Image size 1932x1932.
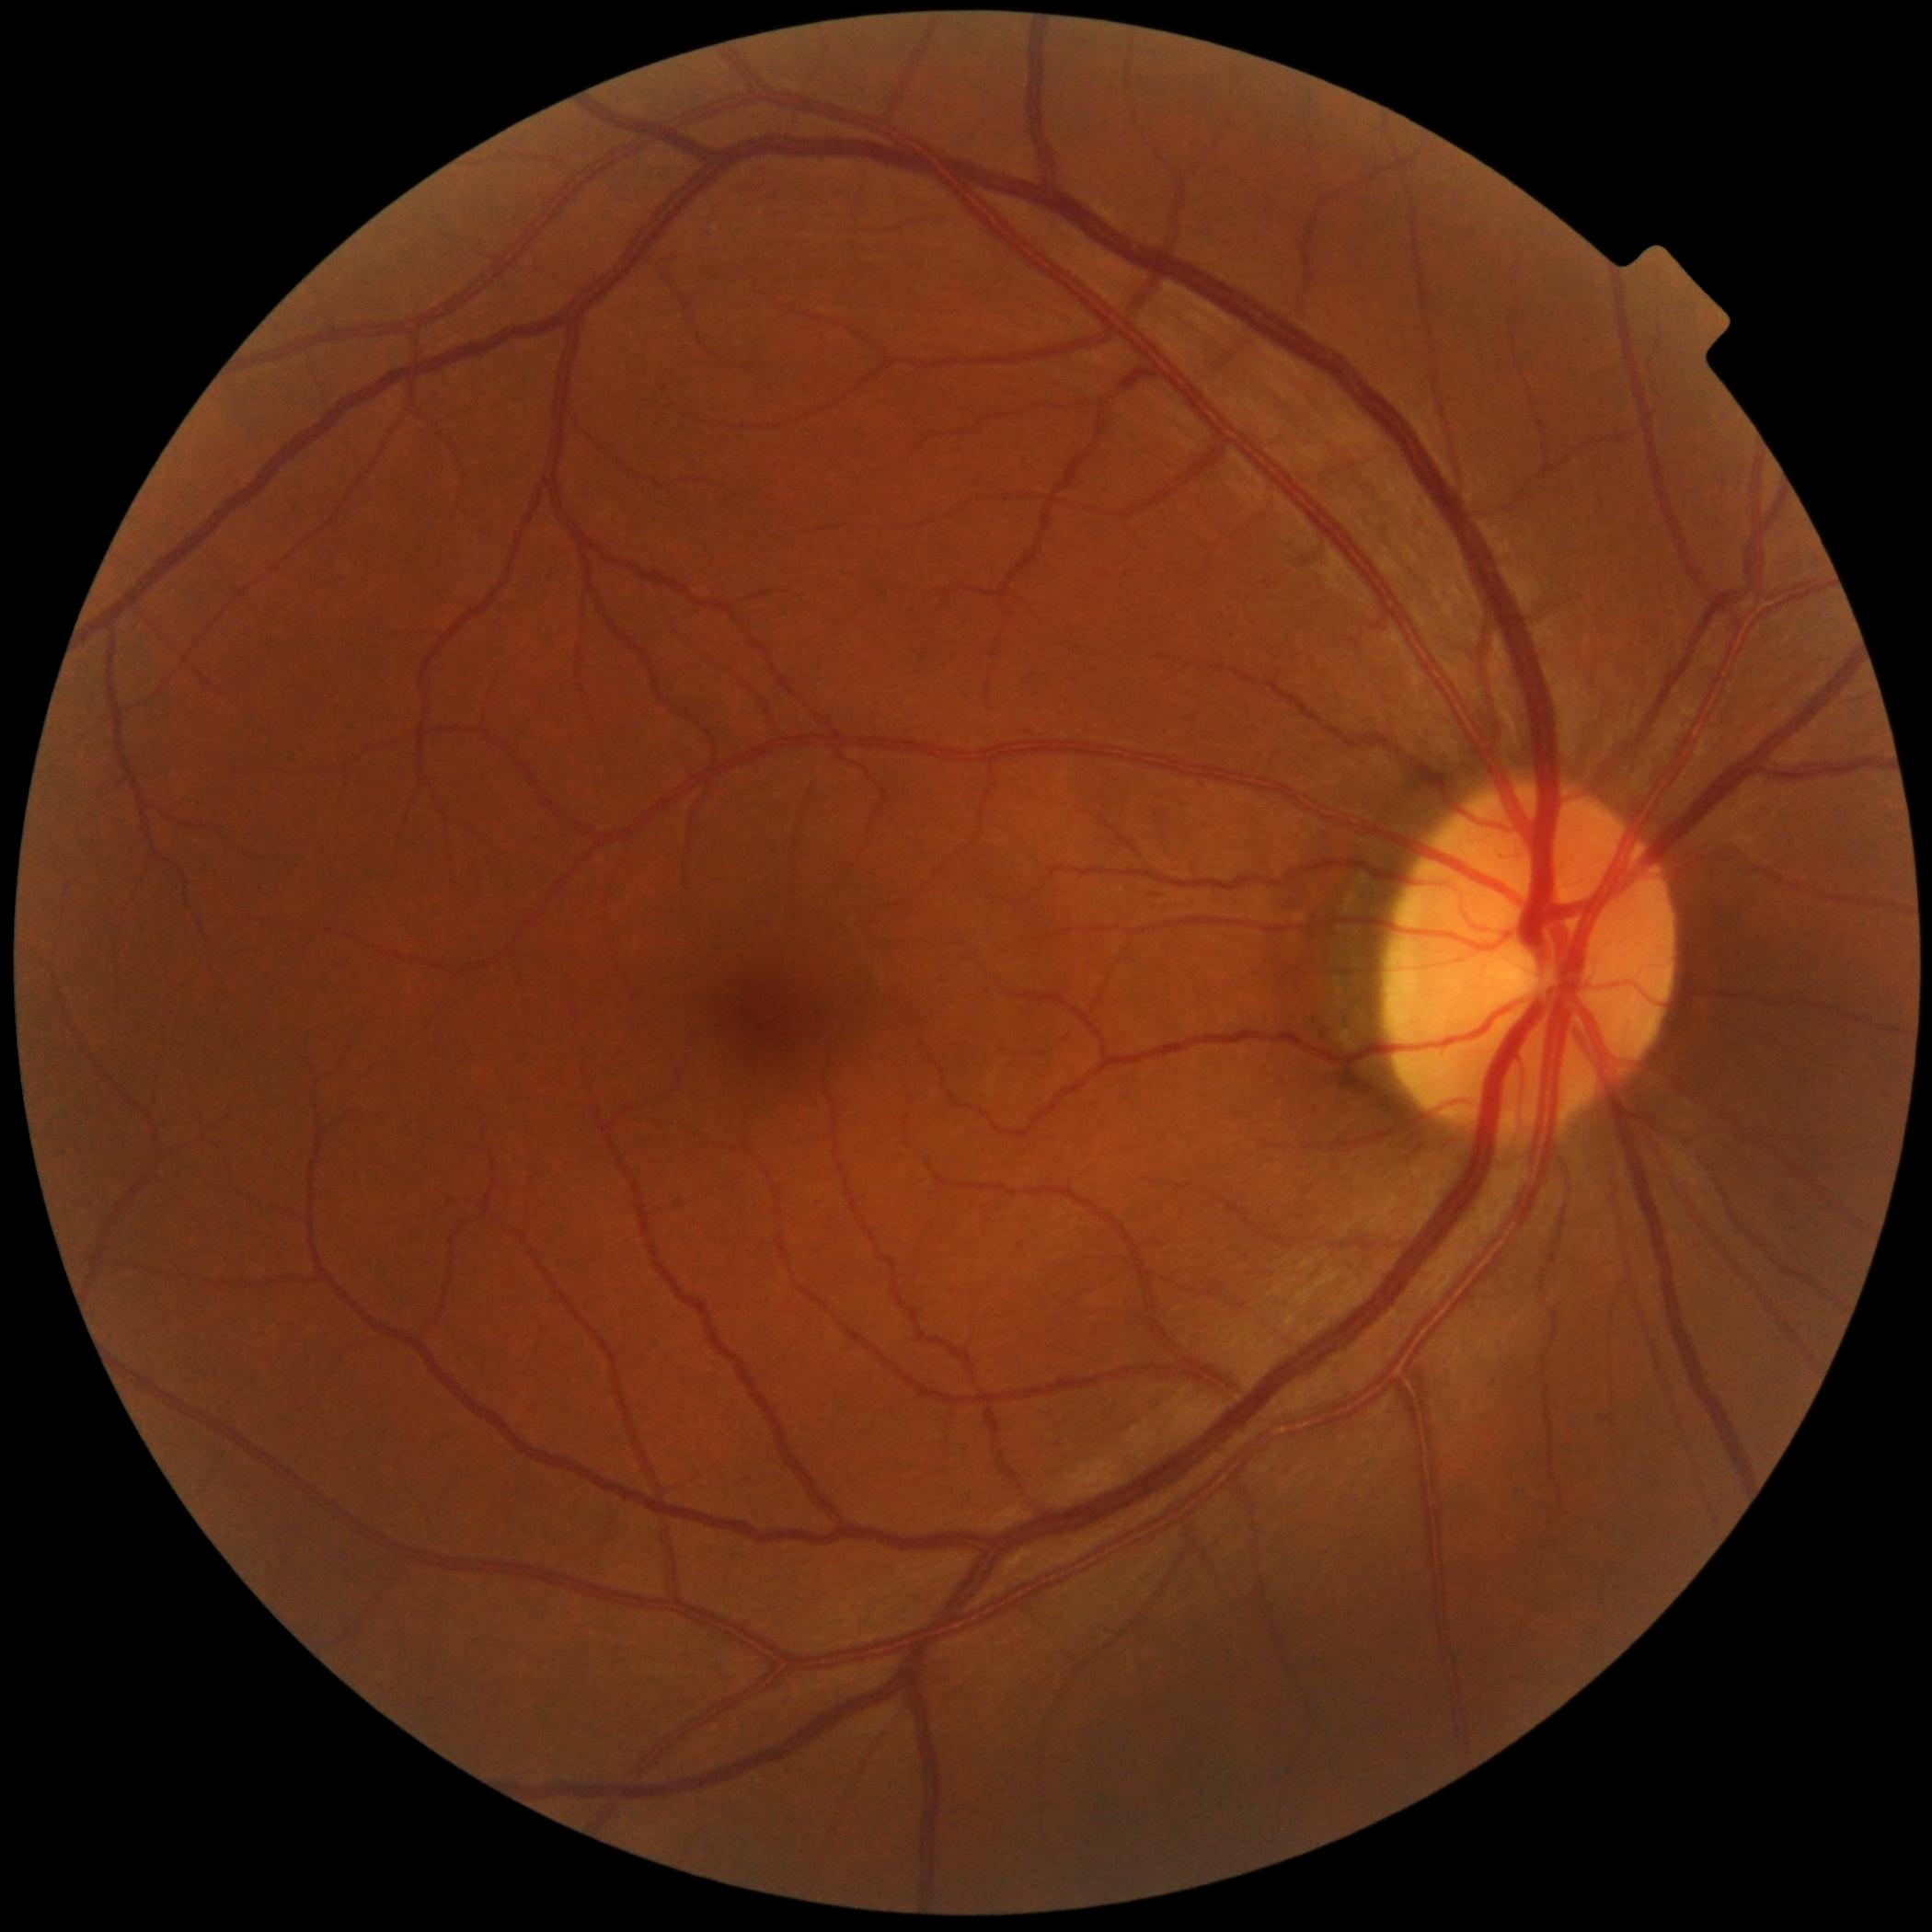

diabetic retinopathy severity = no apparent diabetic retinopathy (grade 0), DR impression = no DR findings.